Modified Davis grading · 848x848:
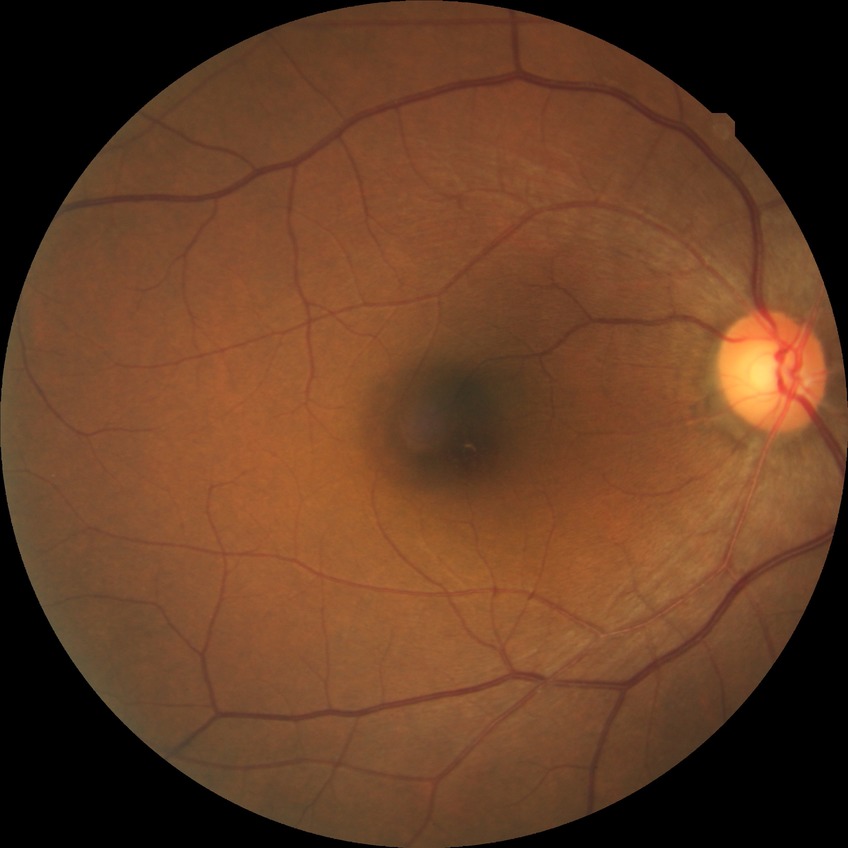
diabetic retinopathy (DR): NDR (no diabetic retinopathy).